Color fundus image; 45° field of view; 2048x1536
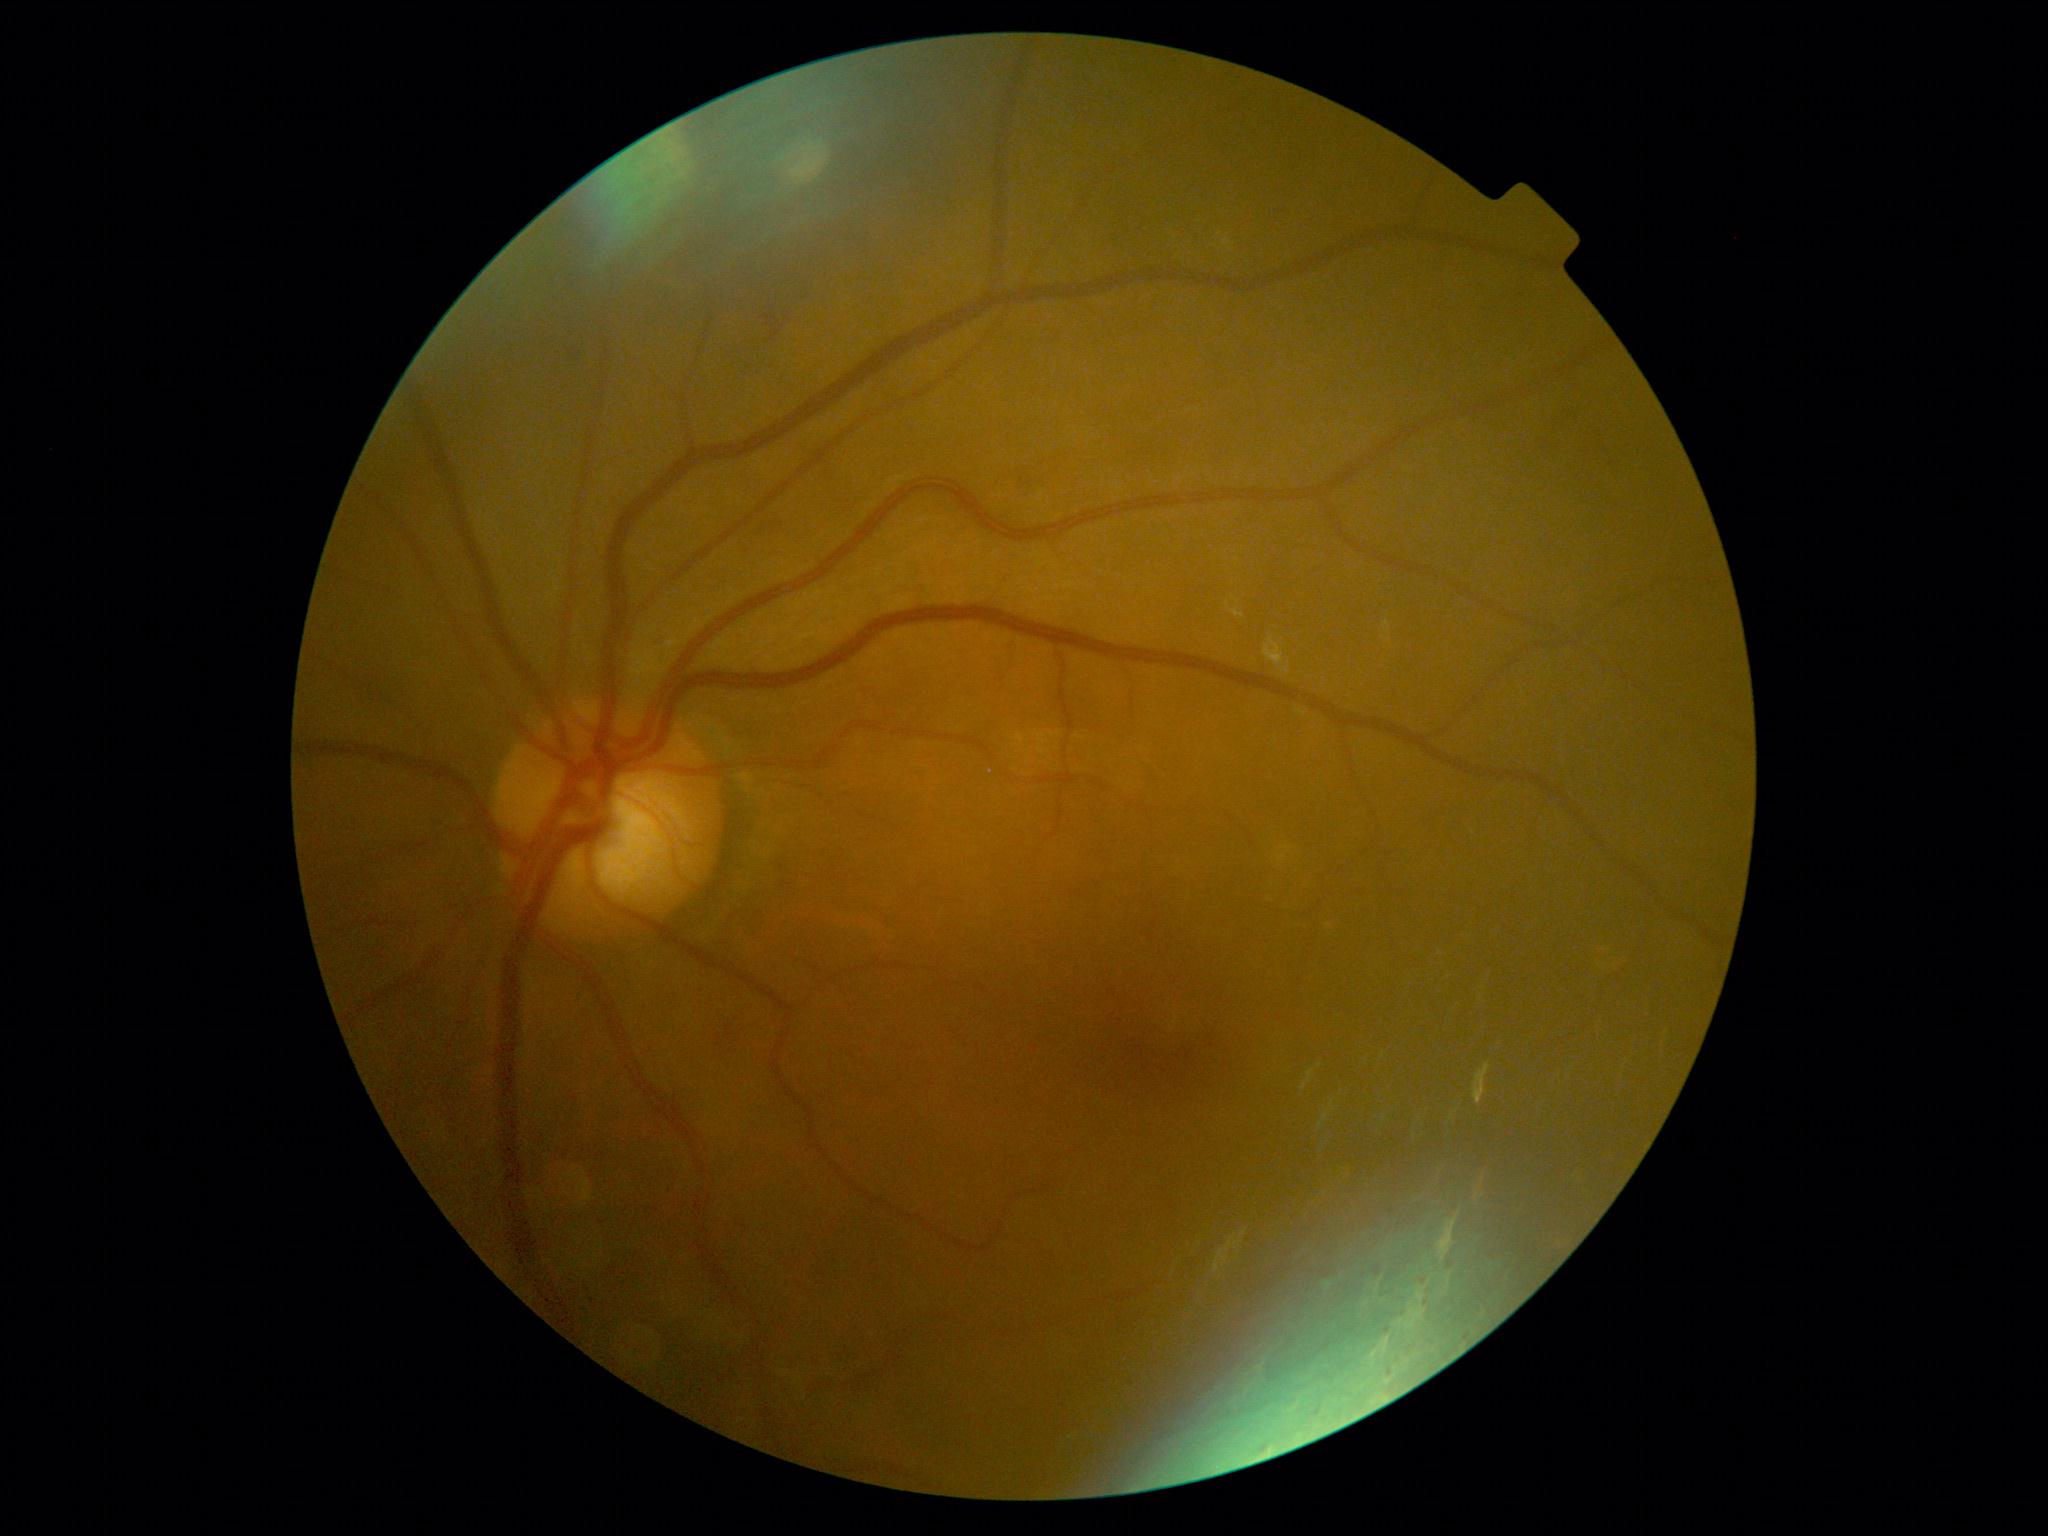 Diabetic retinopathy severity is grade 2 (moderate NPDR).